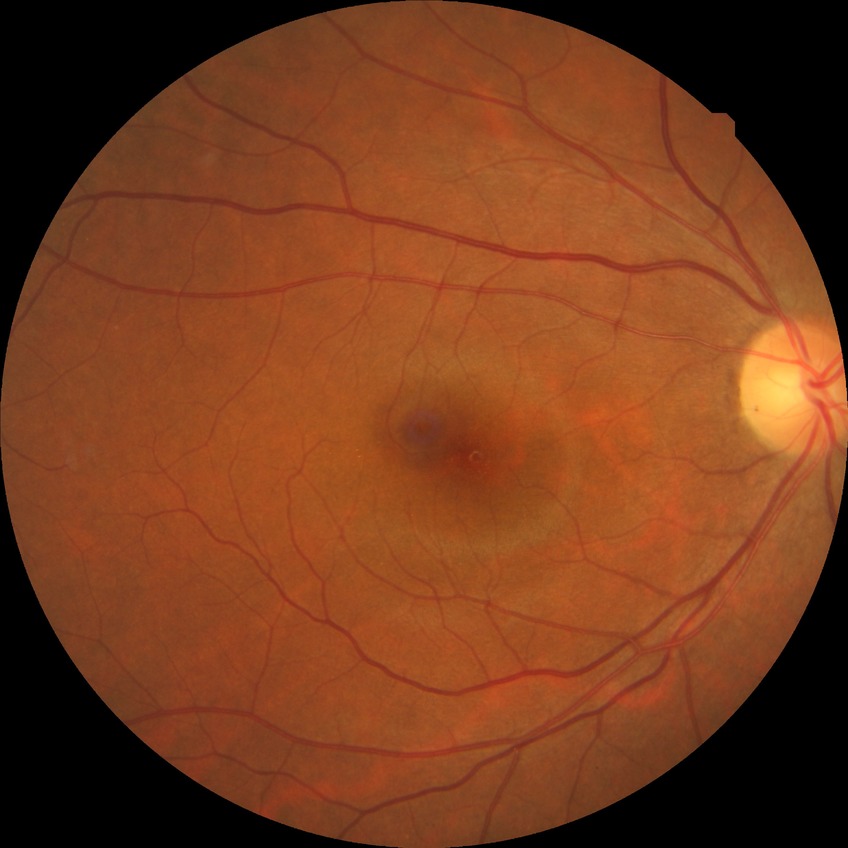 Findings:
* retinopathy stage: no diabetic retinopathy